NIDEK AFC-230, fundus photo:
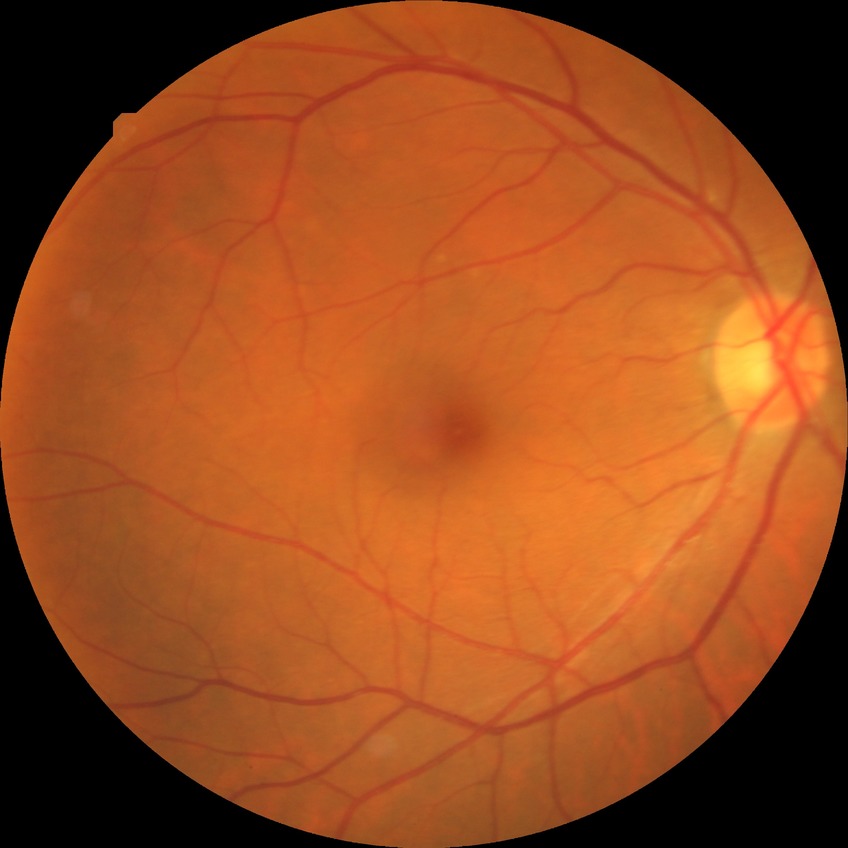
Diabetic retinopathy grade is no diabetic retinopathy.